Nidek AFC-330. 240x240.
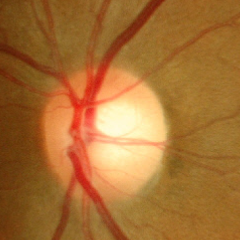

Findings consistent with no glaucoma.